Infant wide-field retinal image:
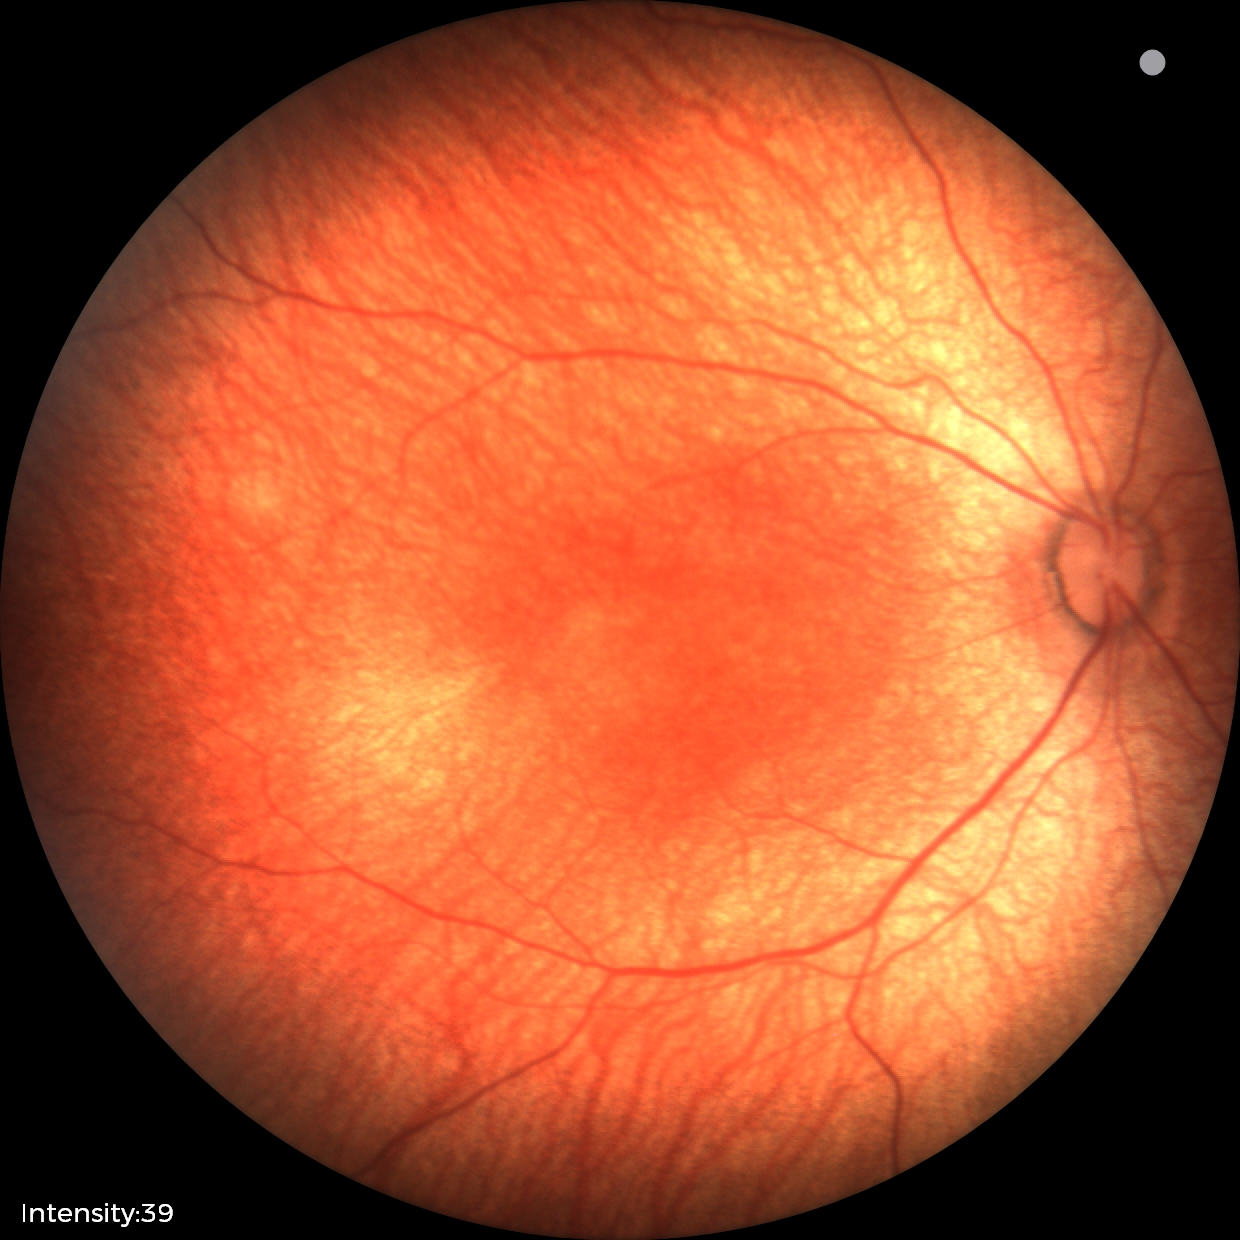 No retinal pathology identified on screening.